Image size 394x394; optic disc region of a color fundus photo; captured with pupil dilation: 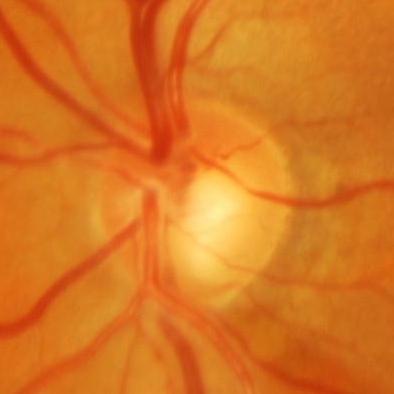

Diagnosis = evidence of glaucoma.